No pharmacologic dilation
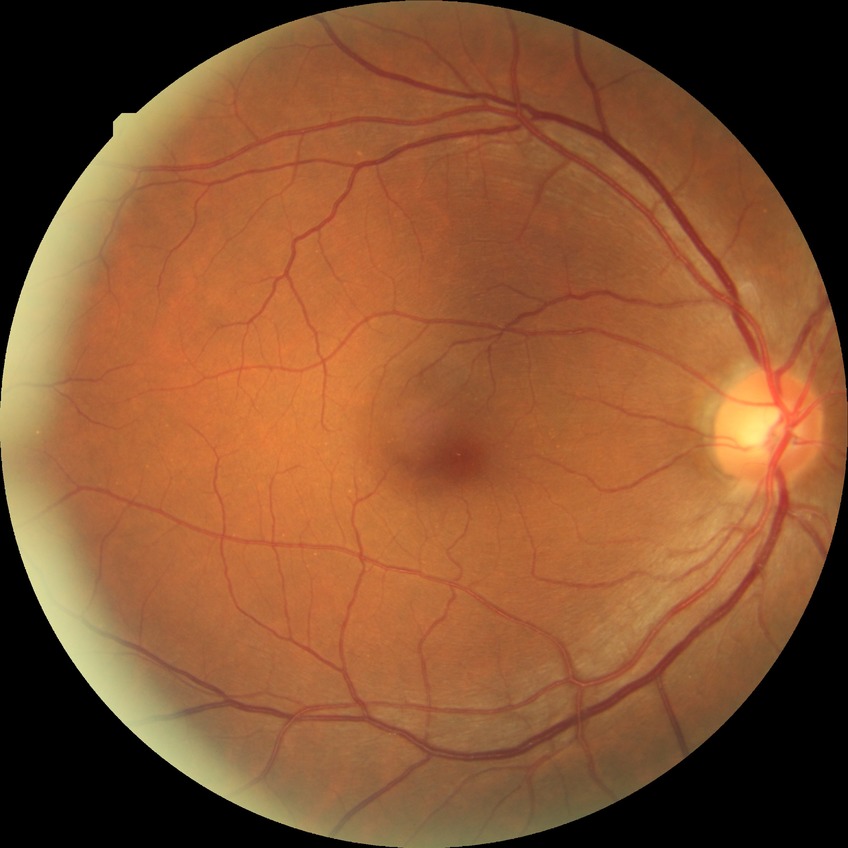
Diabetic retinopathy grade: no diabetic retinopathy.